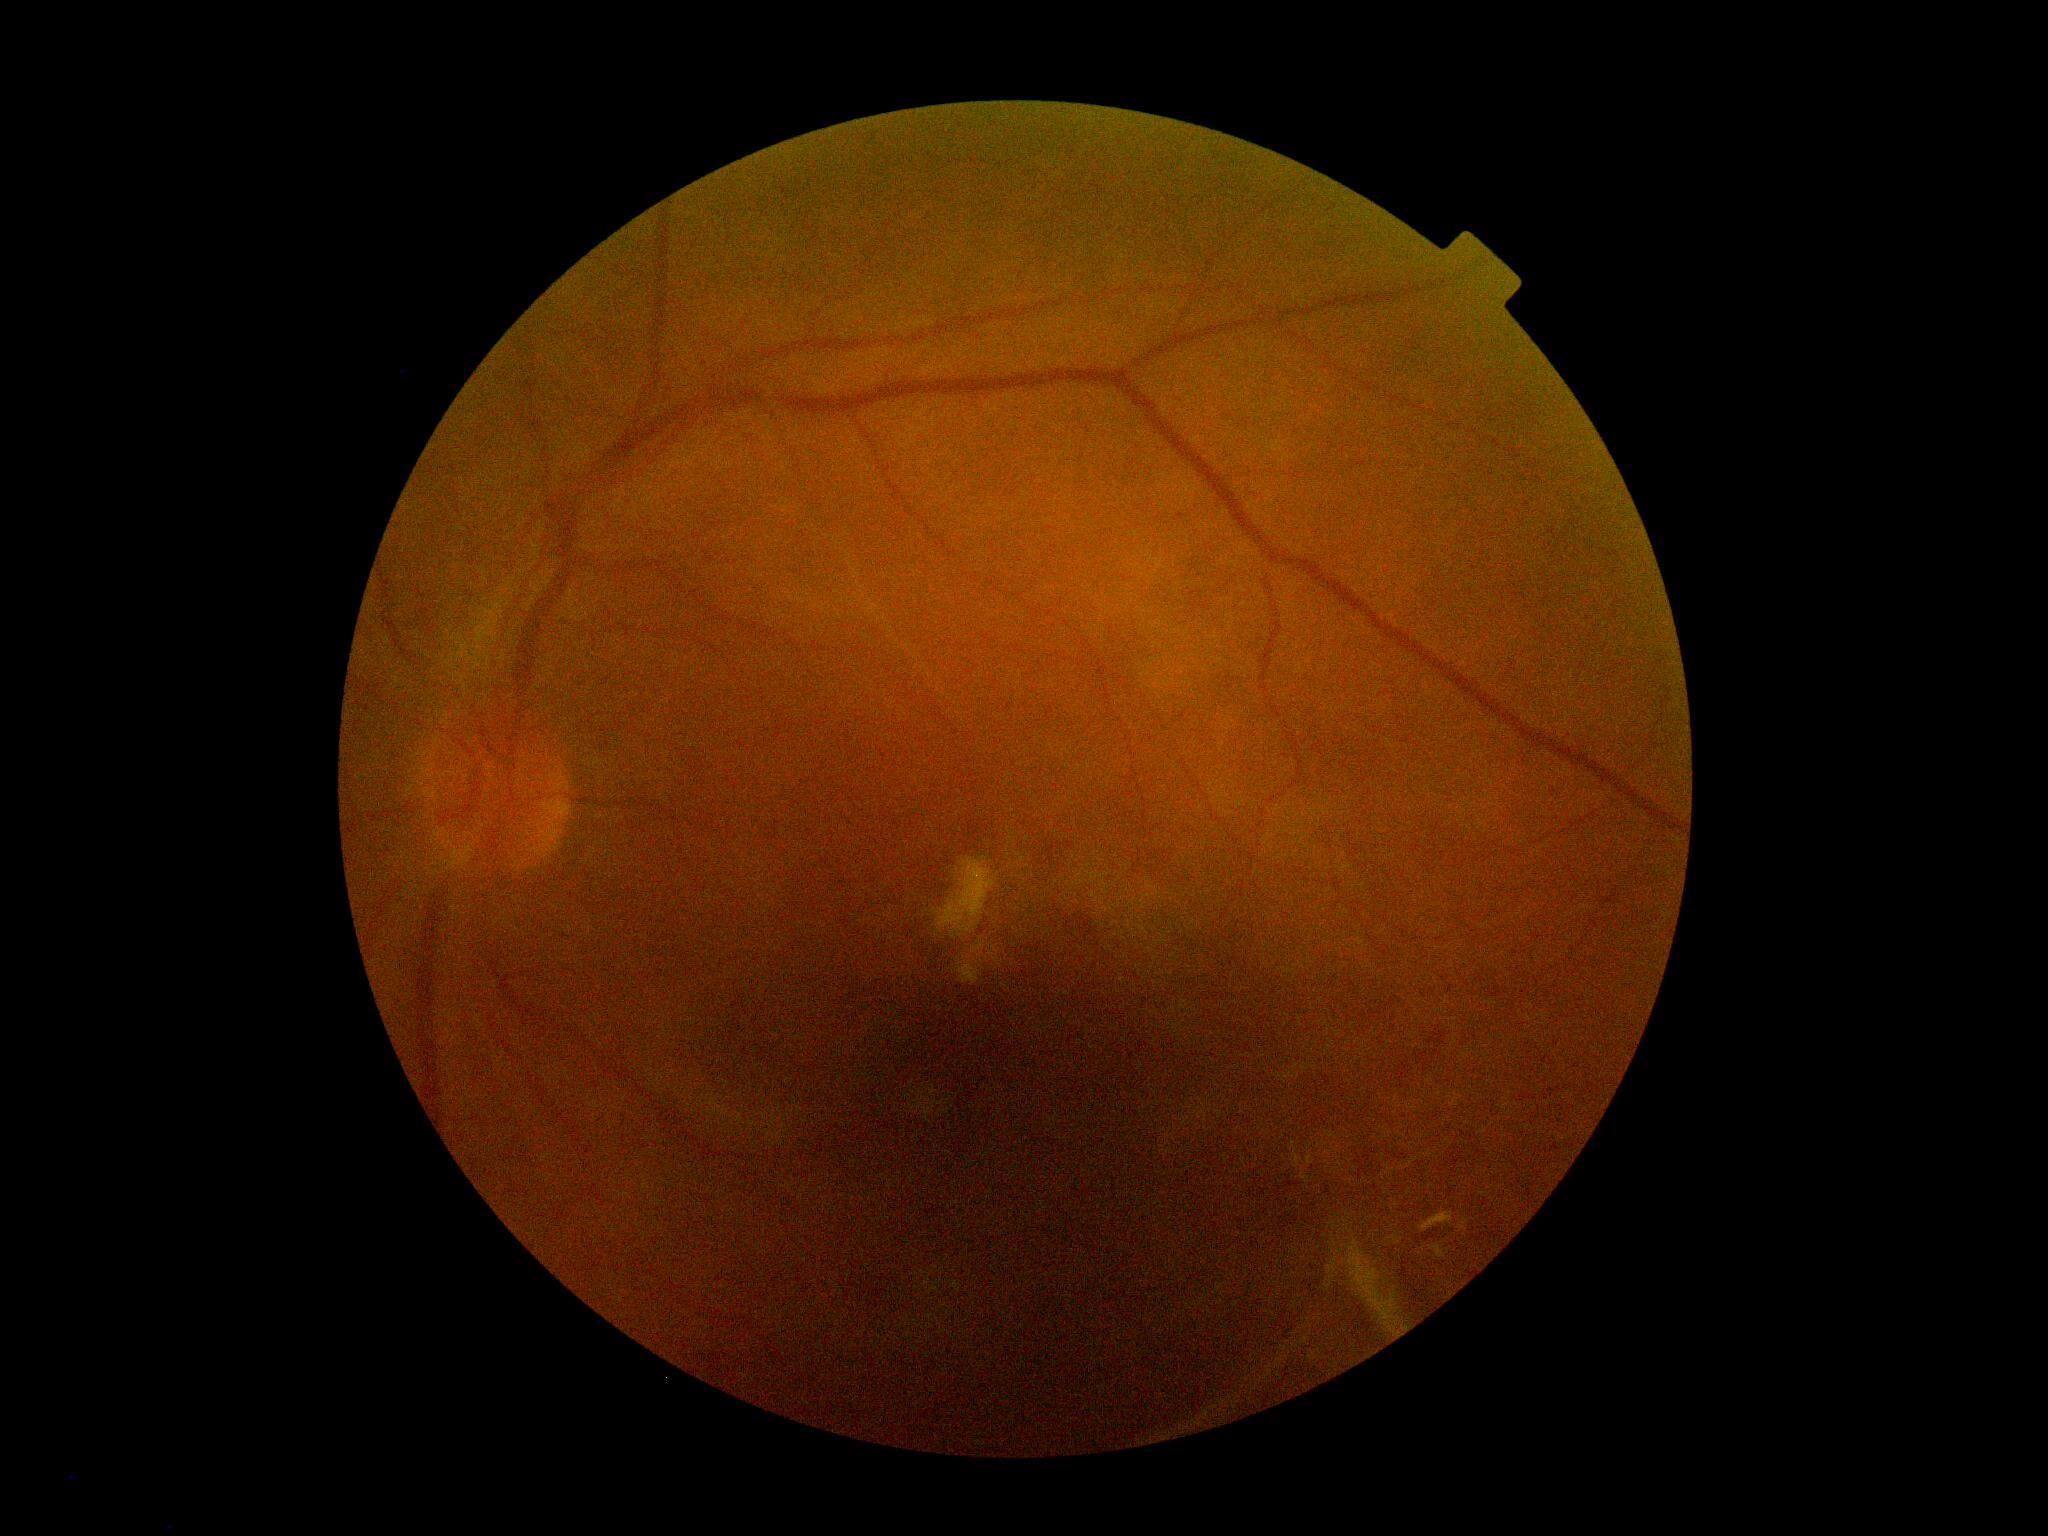 {
  "dr_grade": "proliferative diabetic retinopathy (4) — neovascularization and/or vitreous/pre-retinal hemorrhage"
}